Optic nerve head photograph
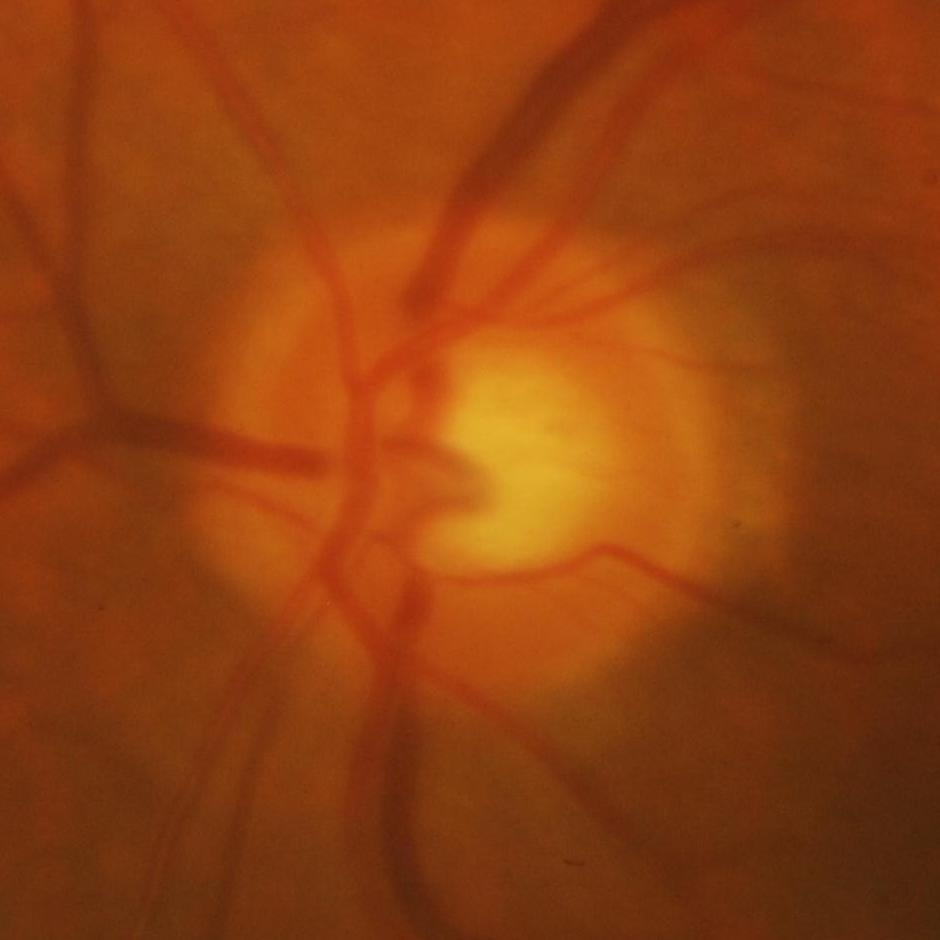
Consistent with glaucomatous damage to the optic nerve.